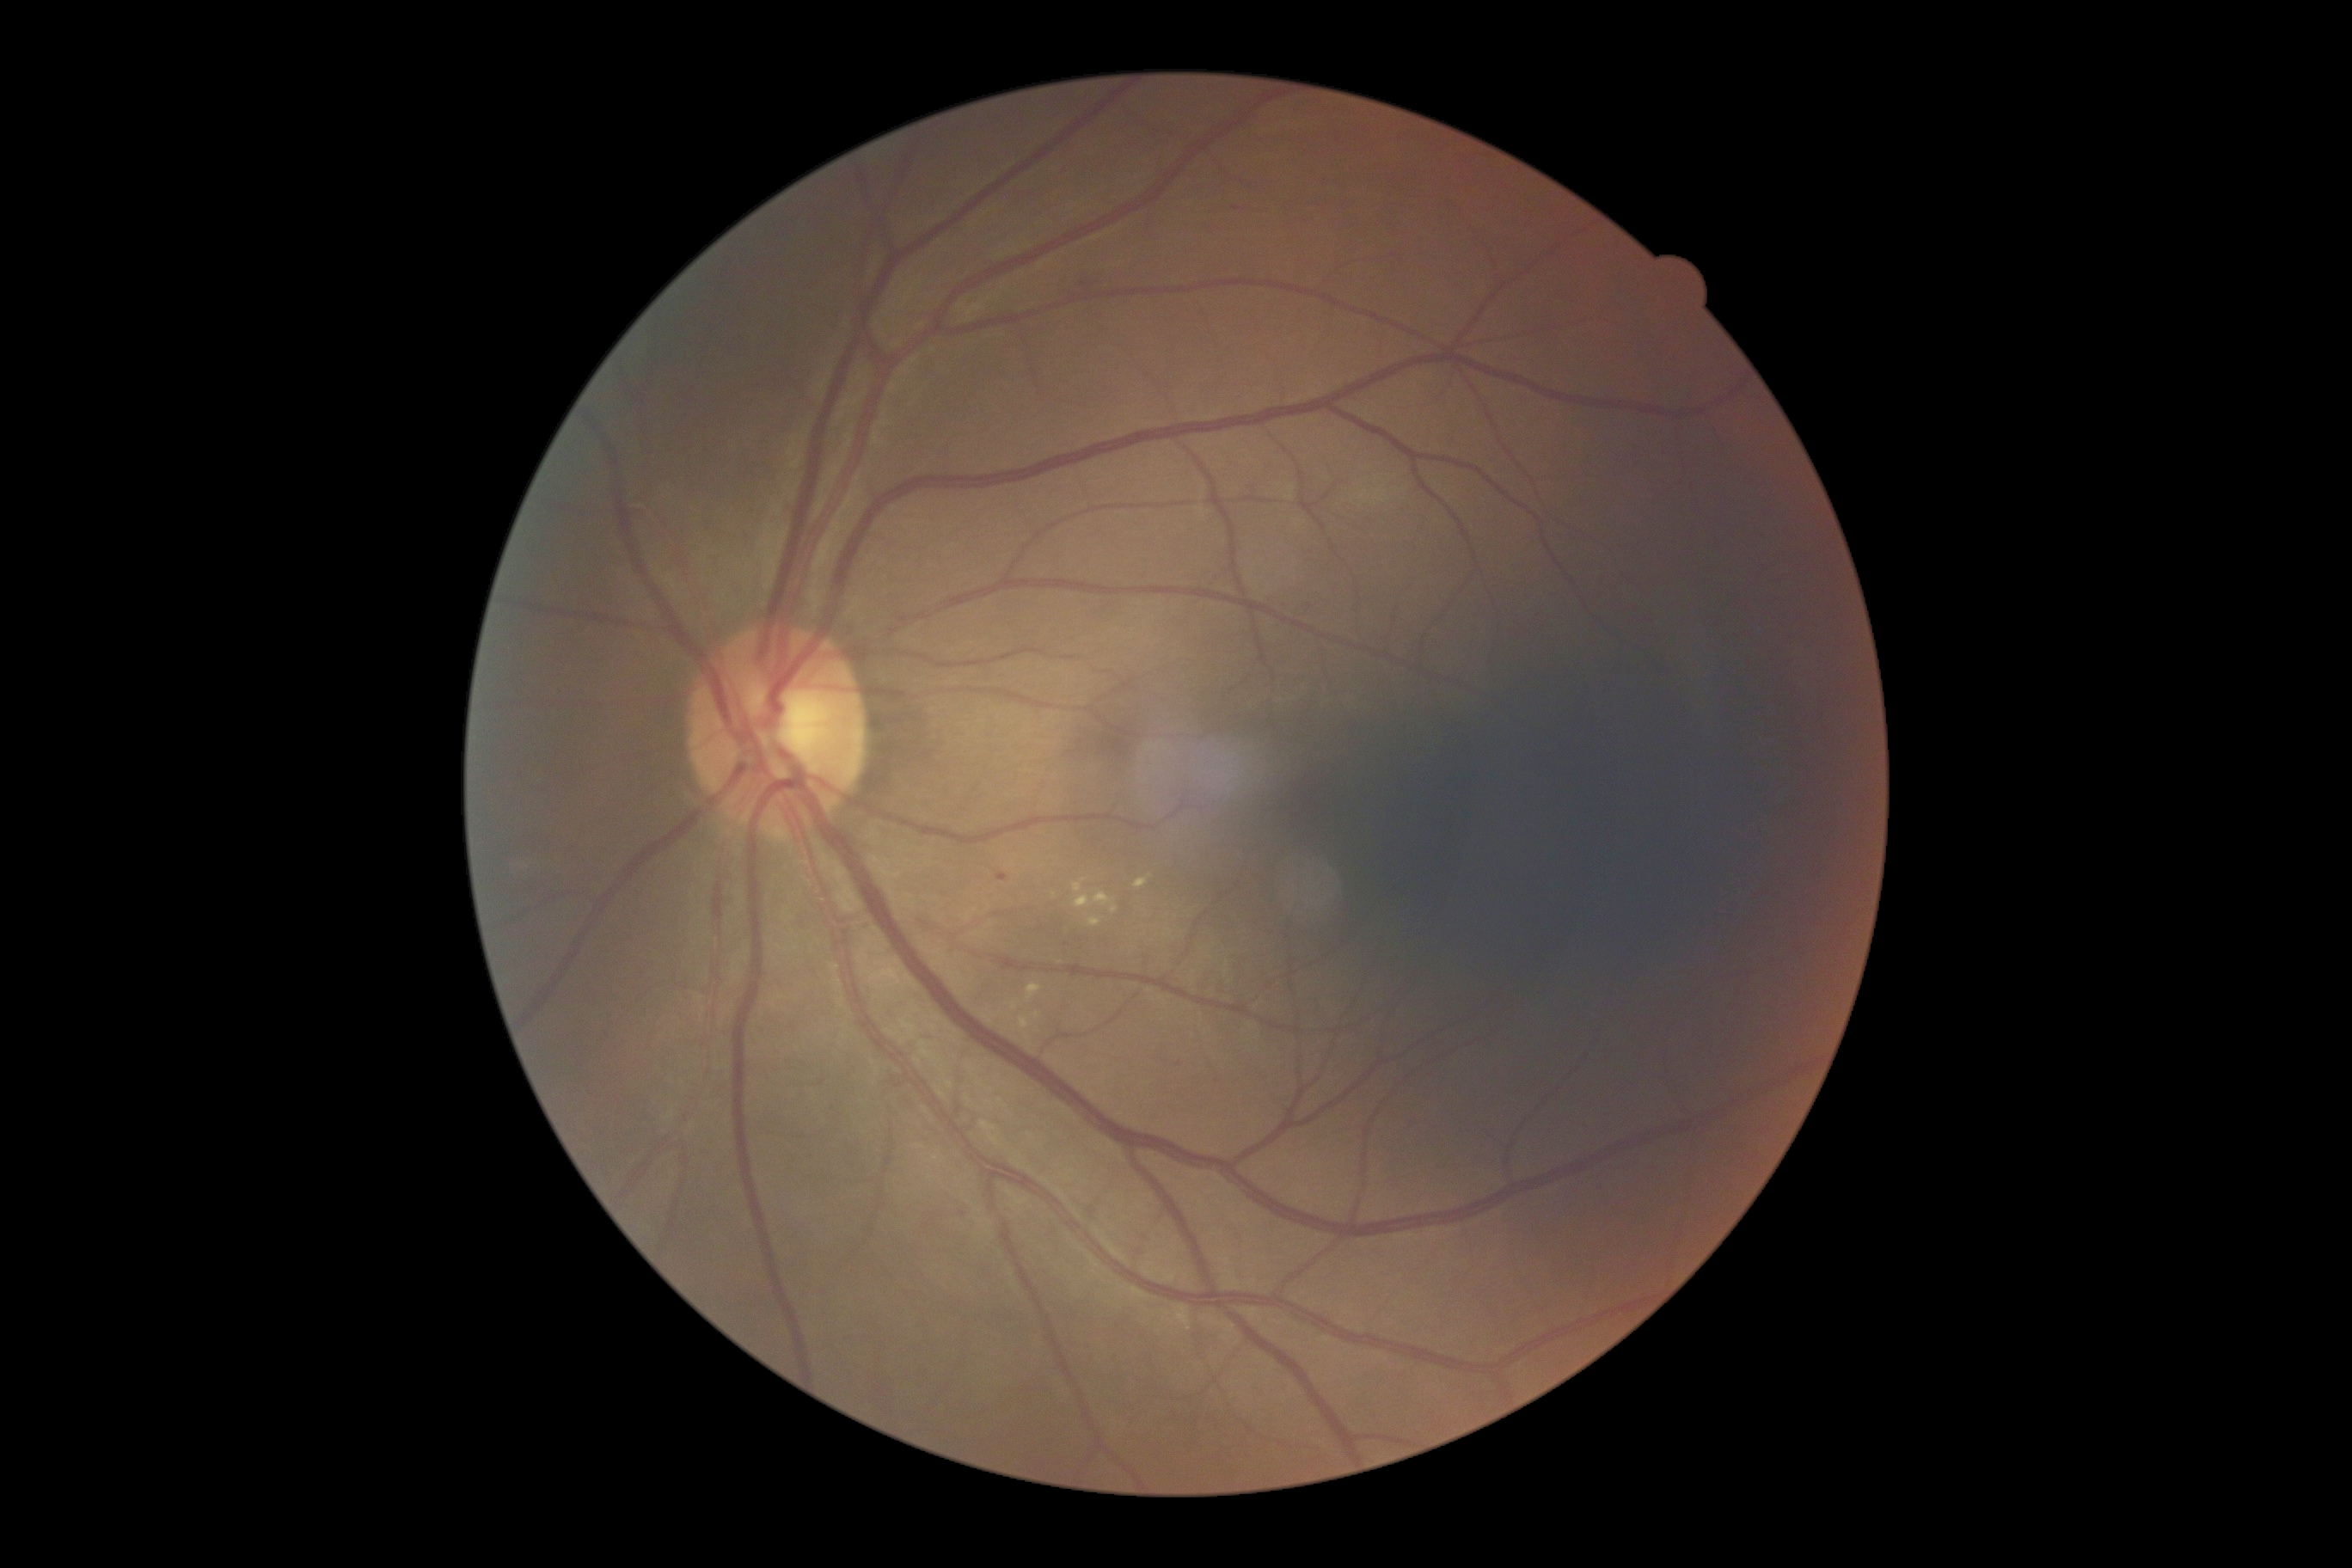

<lesions partial="true">
  <dr_grade>2</dr_grade>
  <se />
  <he />
  <ma>{"left": 996, "top": 874, "right": 1008, "bottom": 883}</ma>
  <ma_small><pt>1085,285</pt></ma_small>
  <ex partial="true">{"left": 1089, "top": 919, "right": 1103, "bottom": 926}; {"left": 1010, "top": 1001, "right": 1020, "bottom": 1012}; {"left": 1134, "top": 874, "right": 1153, "bottom": 890}; {"left": 1026, "top": 984, "right": 1043, "bottom": 1005}; {"left": 1019, "top": 1012, "right": 1043, "bottom": 1048}; {"left": 1074, "top": 879, "right": 1086, "bottom": 893}; {"left": 1094, "top": 891, "right": 1118, "bottom": 914}; {"left": 1074, "top": 897, "right": 1091, "bottom": 910}</ex>
  <ex_small><pt>1054,895</pt>; <pt>1167,931</pt></ex_small>
</lesions>